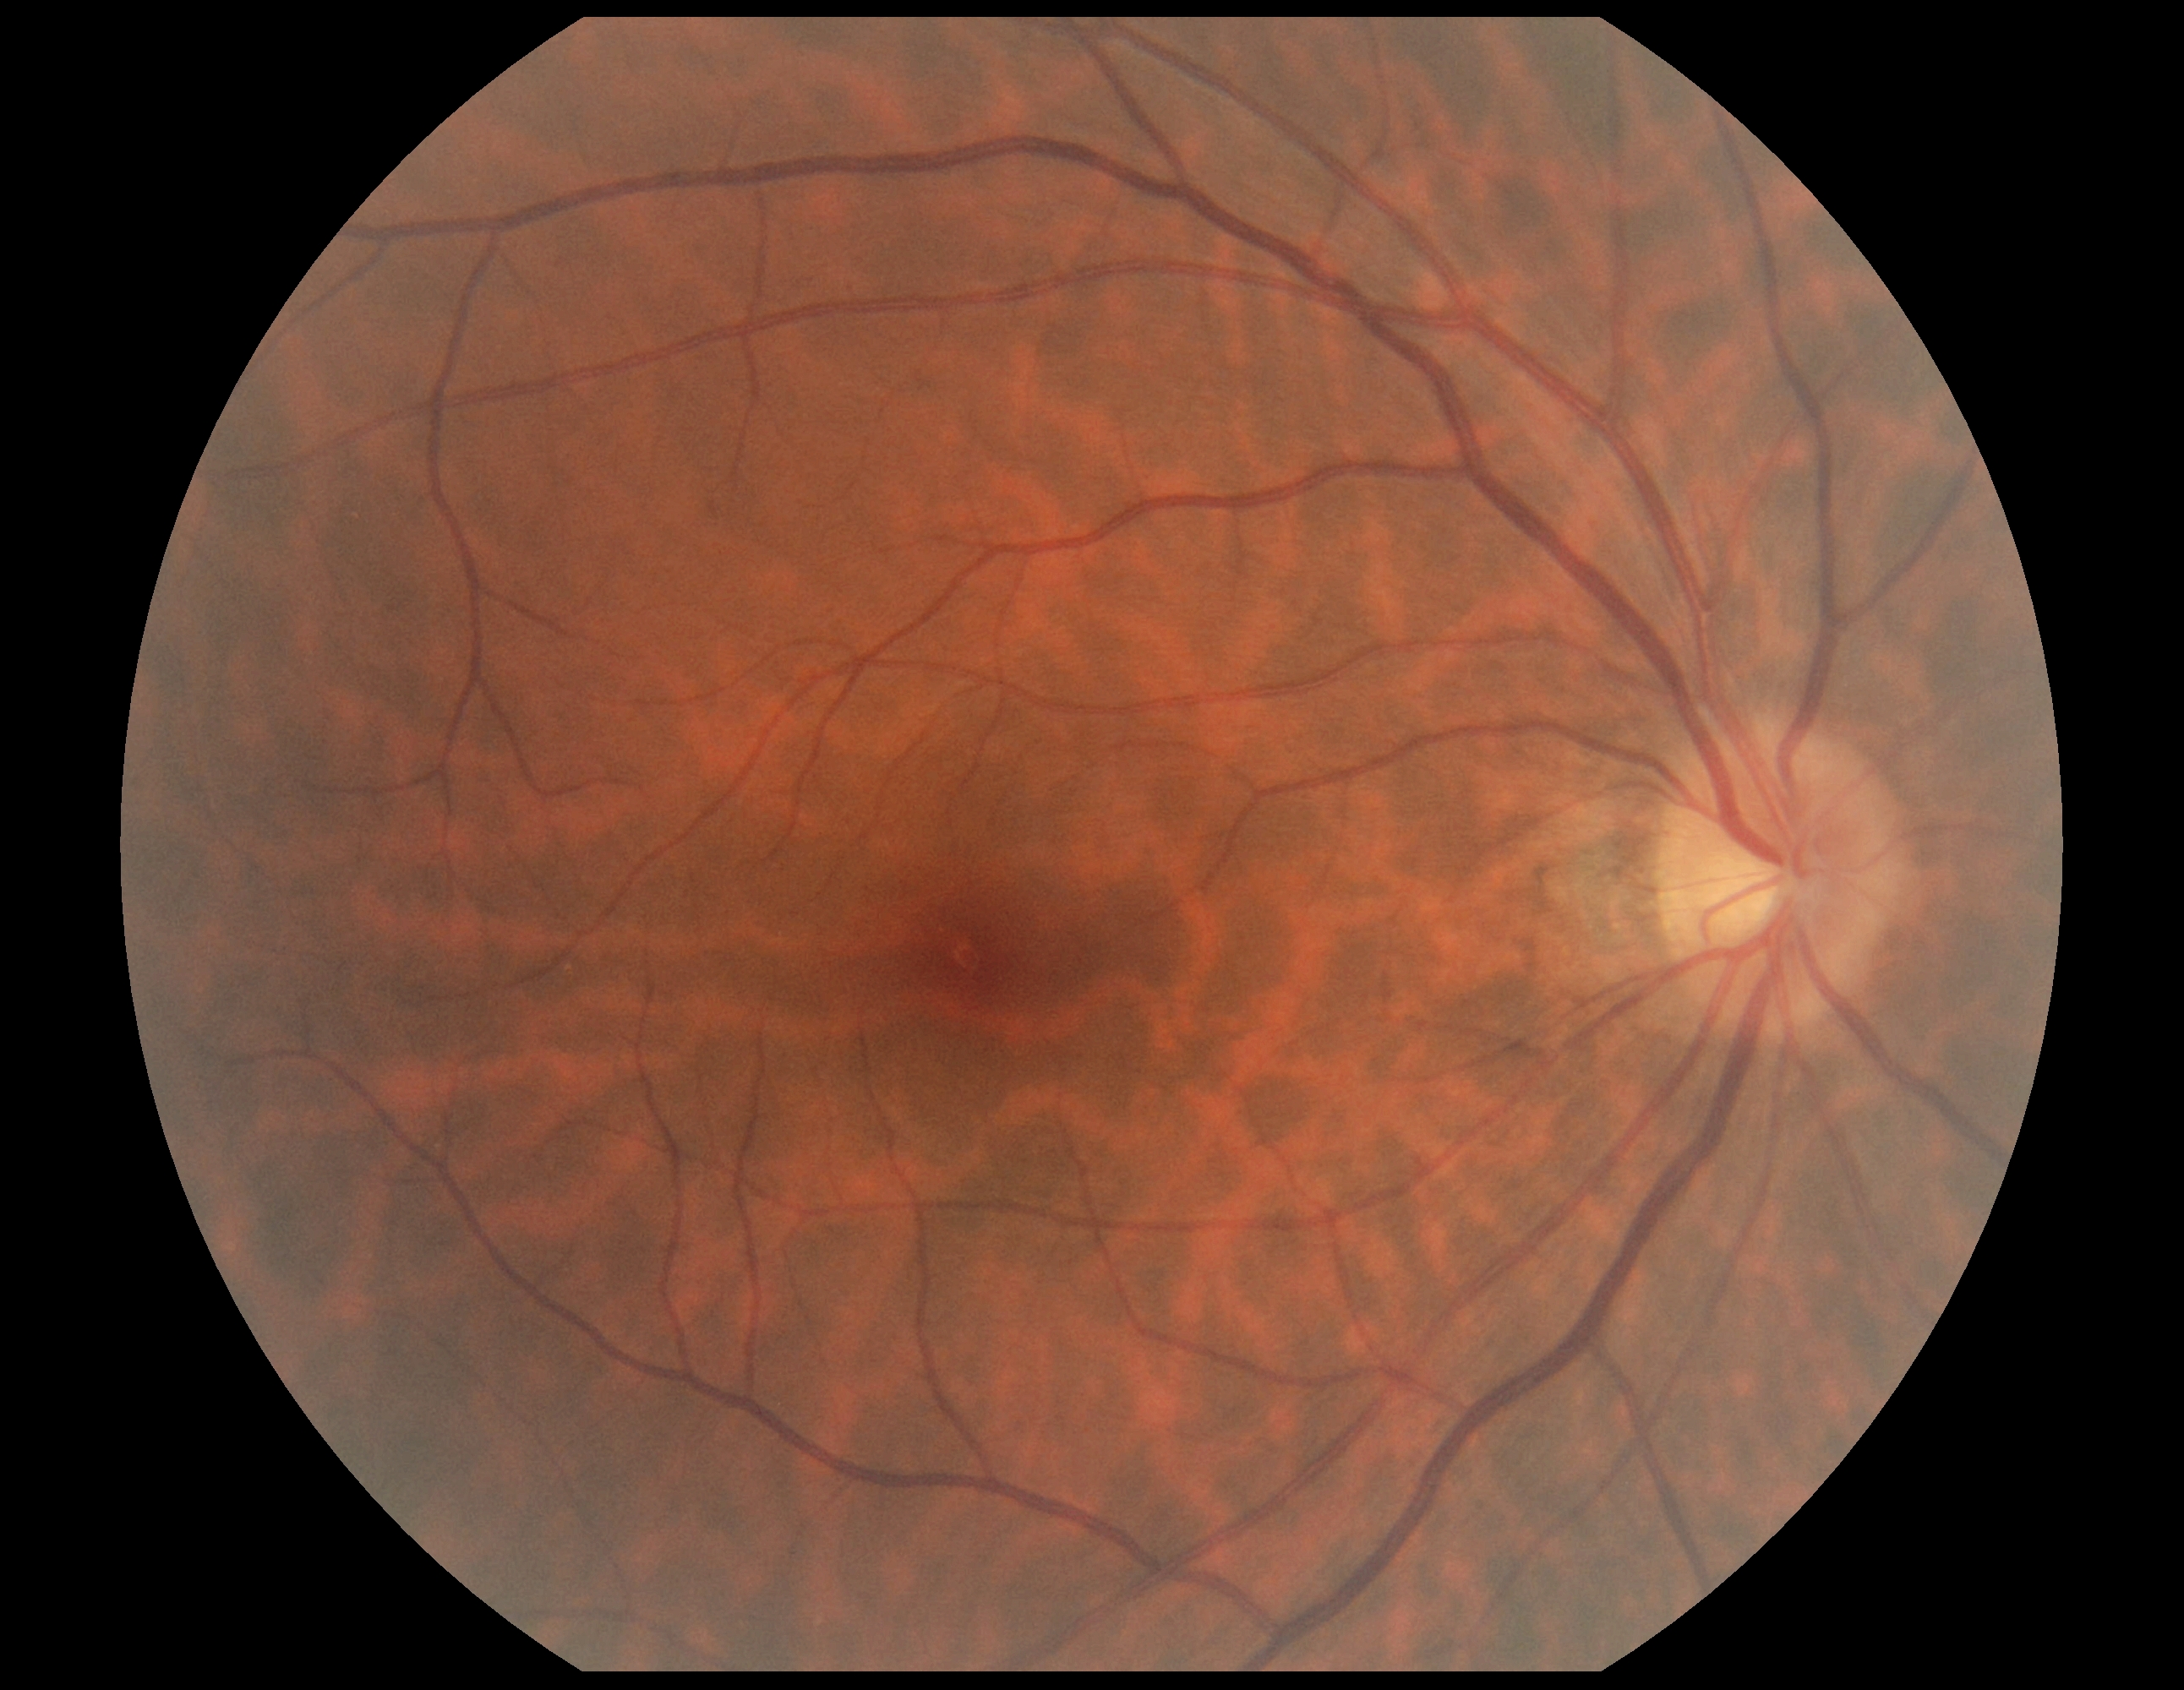 retinopathy = no apparent retinopathy (grade 0).